45 degree fundus photograph. Image size 848x848. CFP: 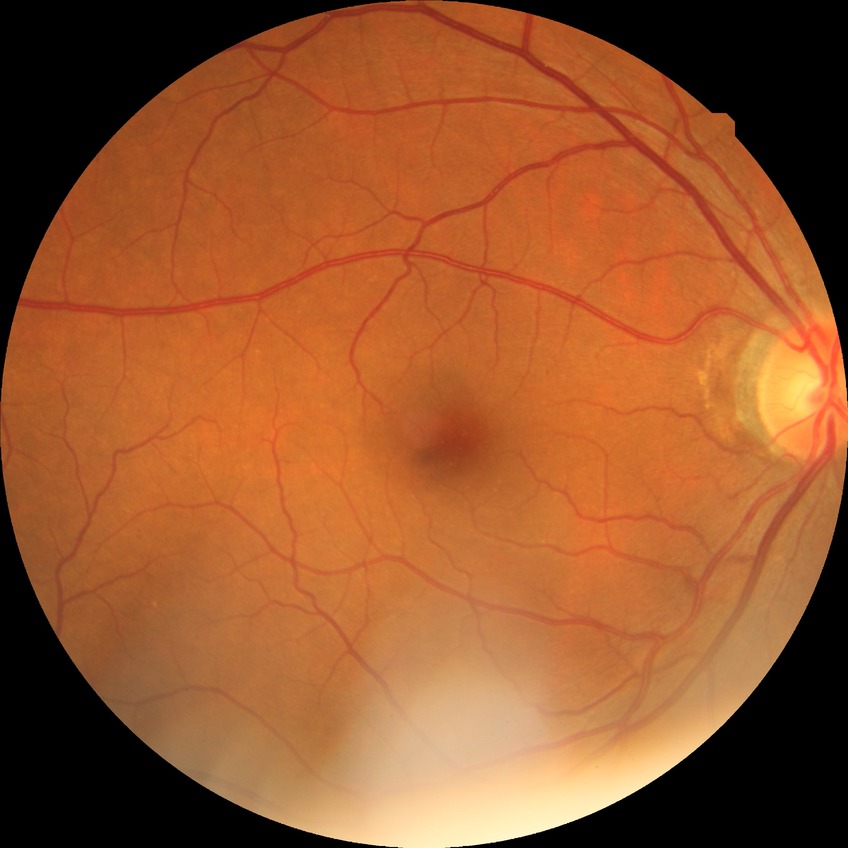

Diabetic retinopathy (DR): no diabetic retinopathy (NDR).